Optic disc-centered crop from a color fundus photograph — 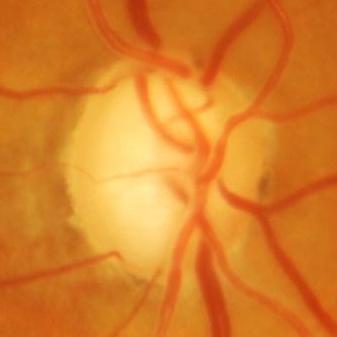 Optic disc appearance consistent with glaucomatous findings.